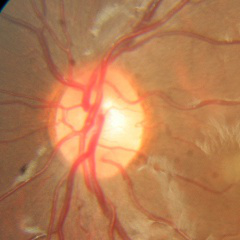

Glaucoma assessment = no glaucomatous optic neuropathy.